Camera: NIDEK AFC-230:
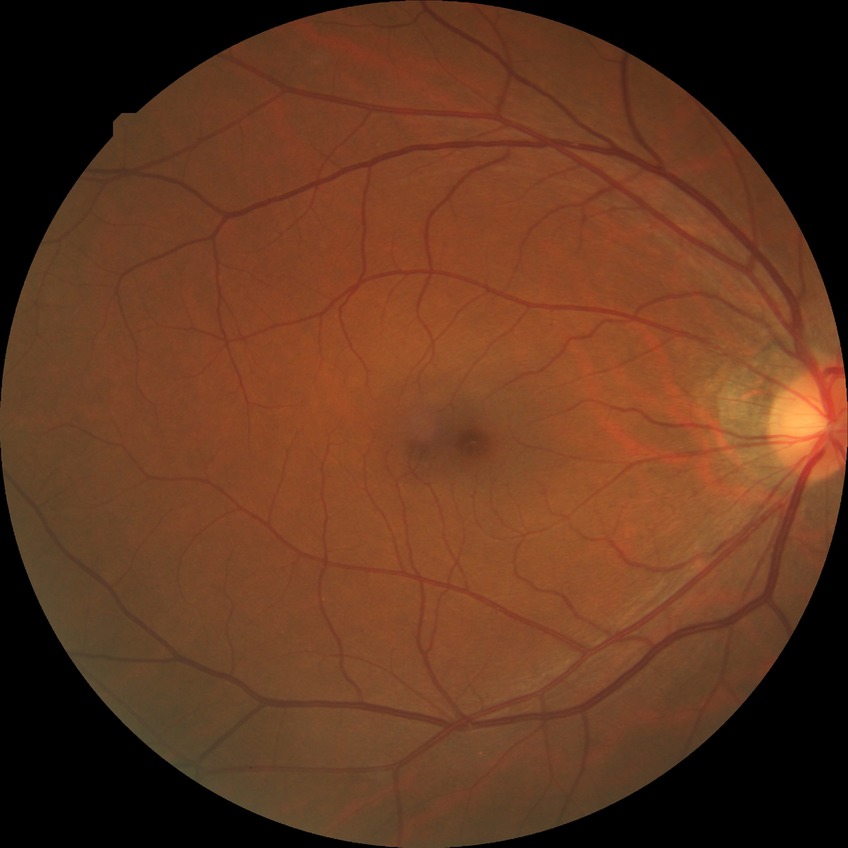

Diabetic retinopathy (DR): no diabetic retinopathy (NDR).